640 x 480 pixels; acquired on the Clarity RetCam 3; RetCam wide-field infant fundus image
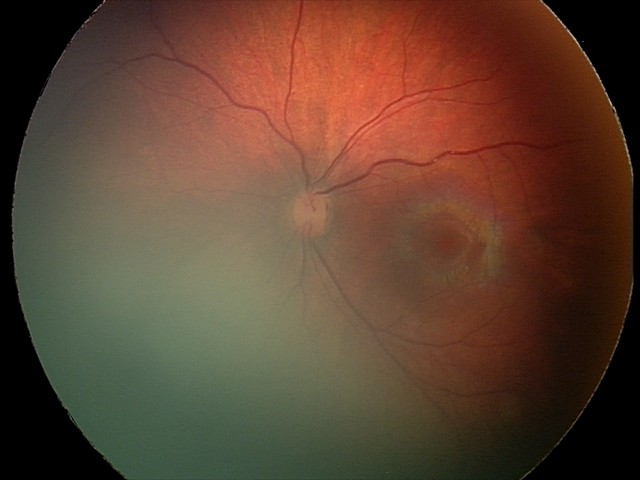

From an examination with diagnosis of retinal hemorrhages.